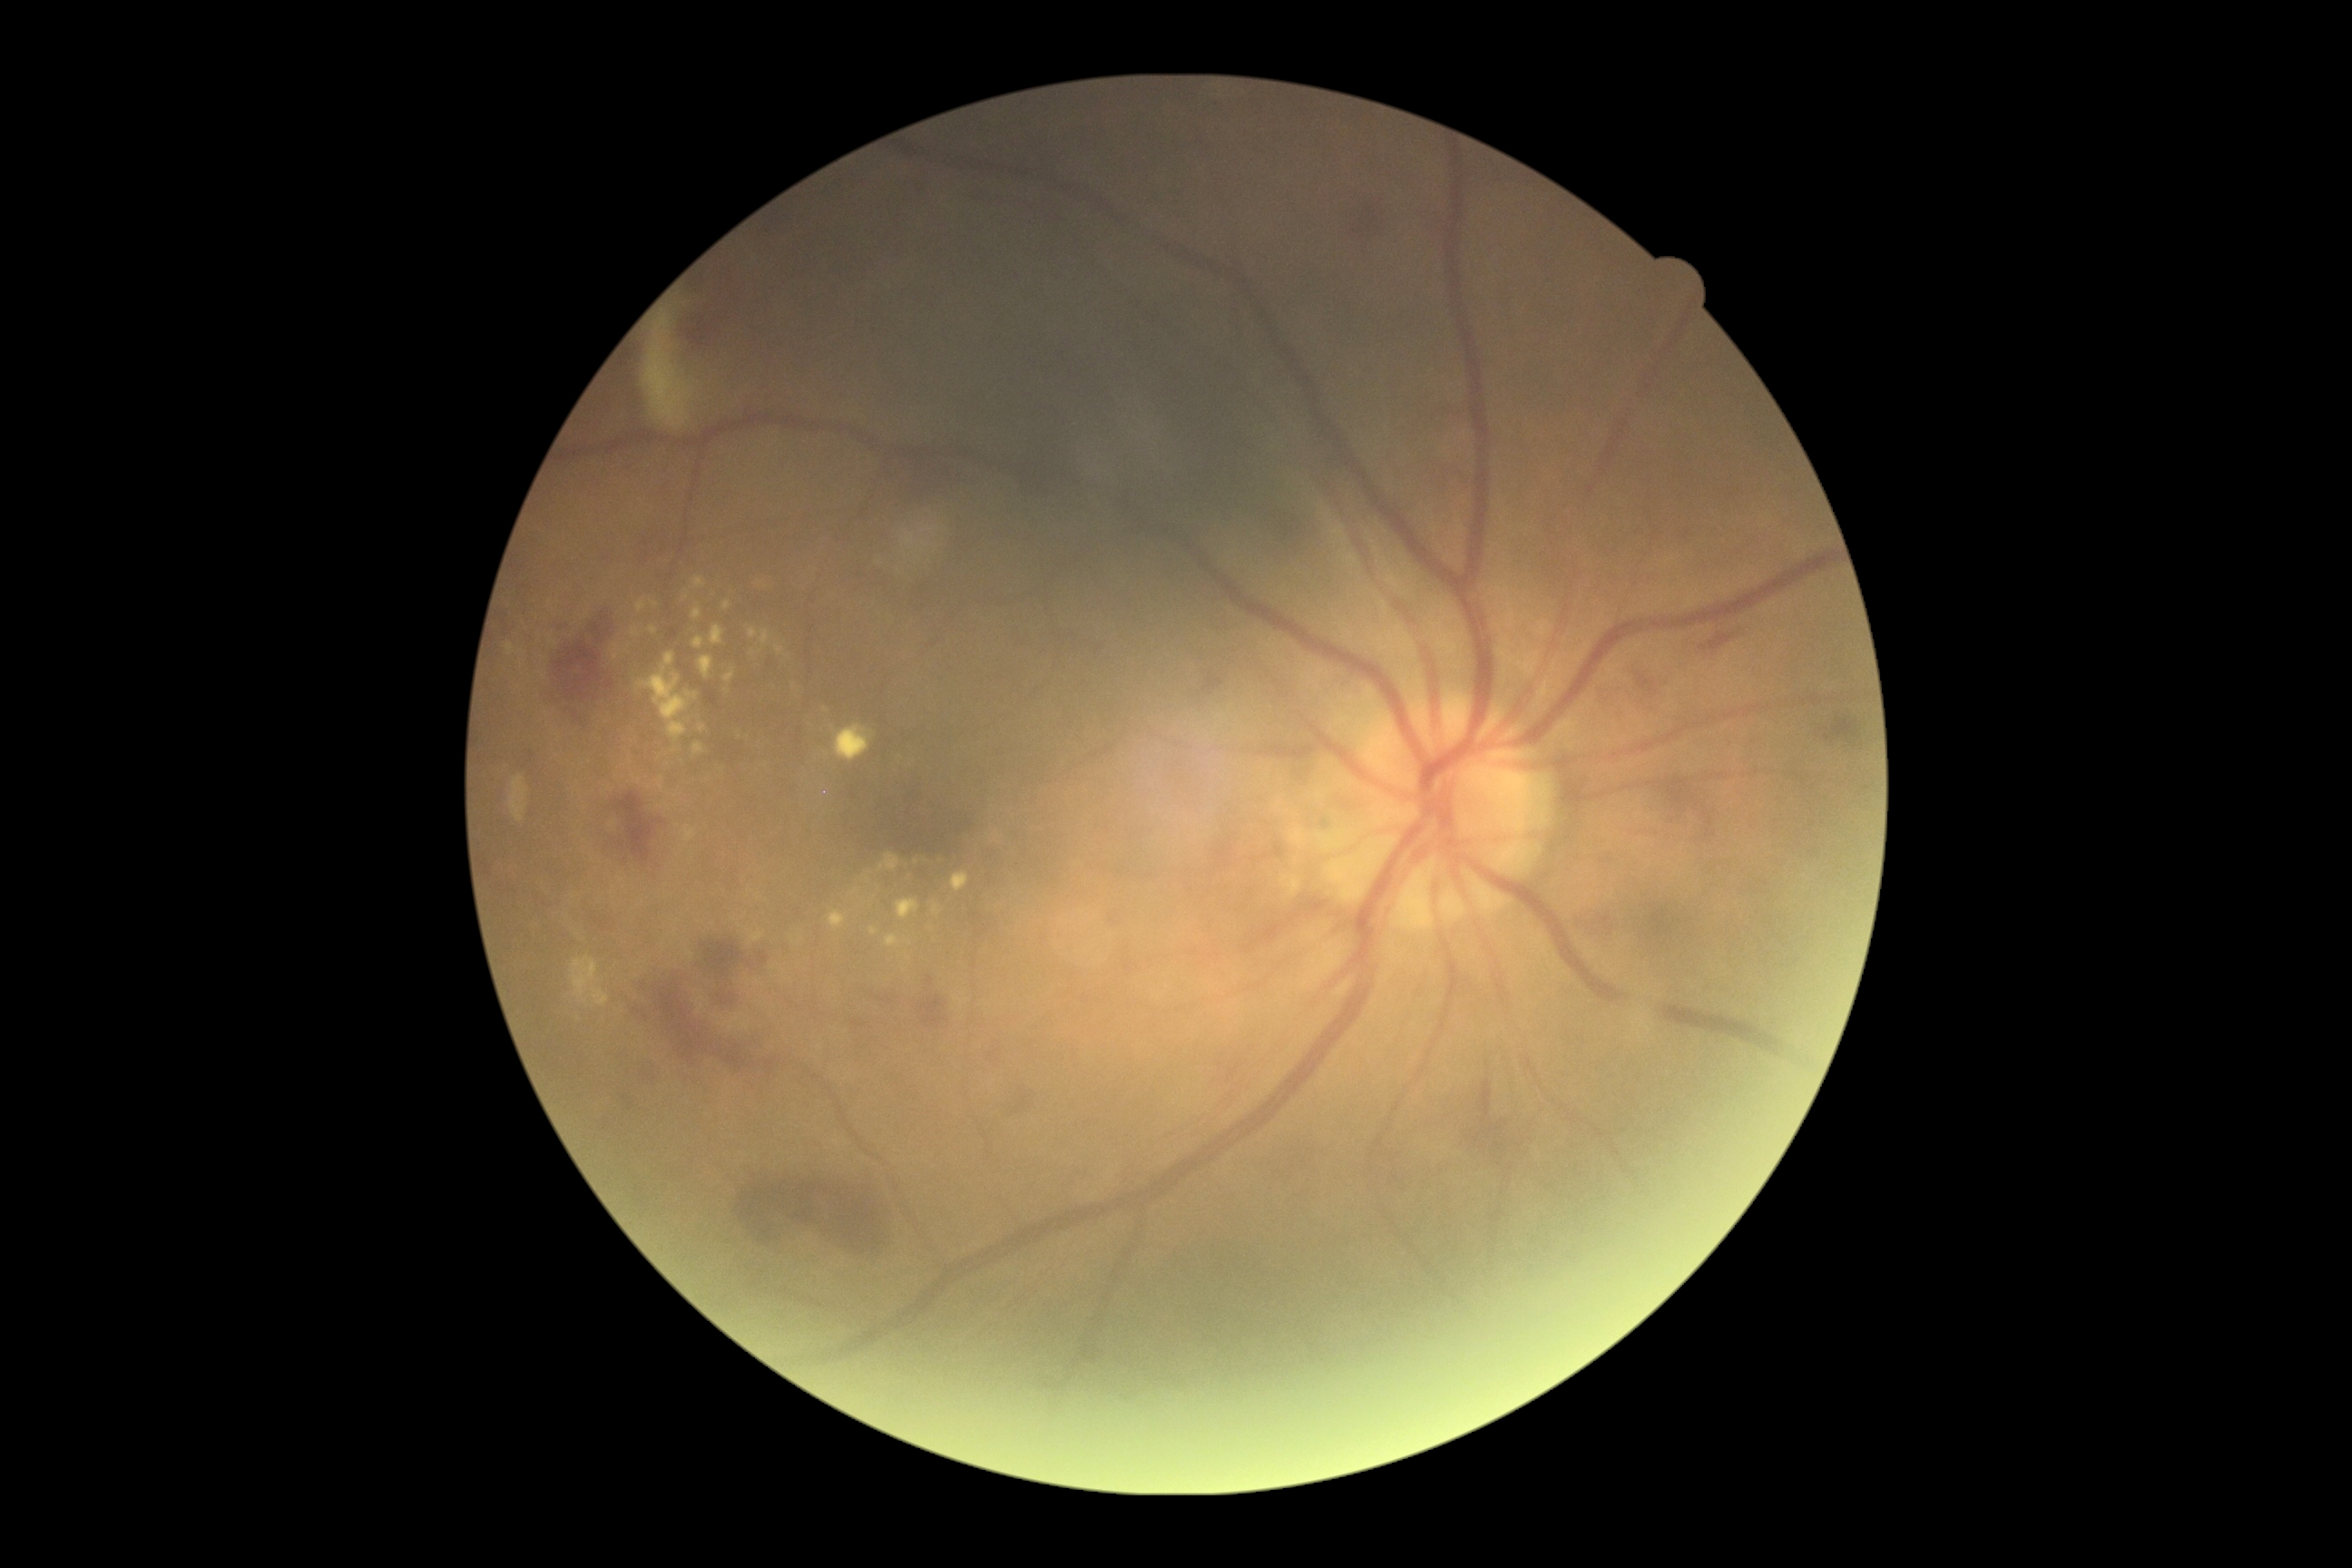 DR class@non-proliferative diabetic retinopathy, DR@2.